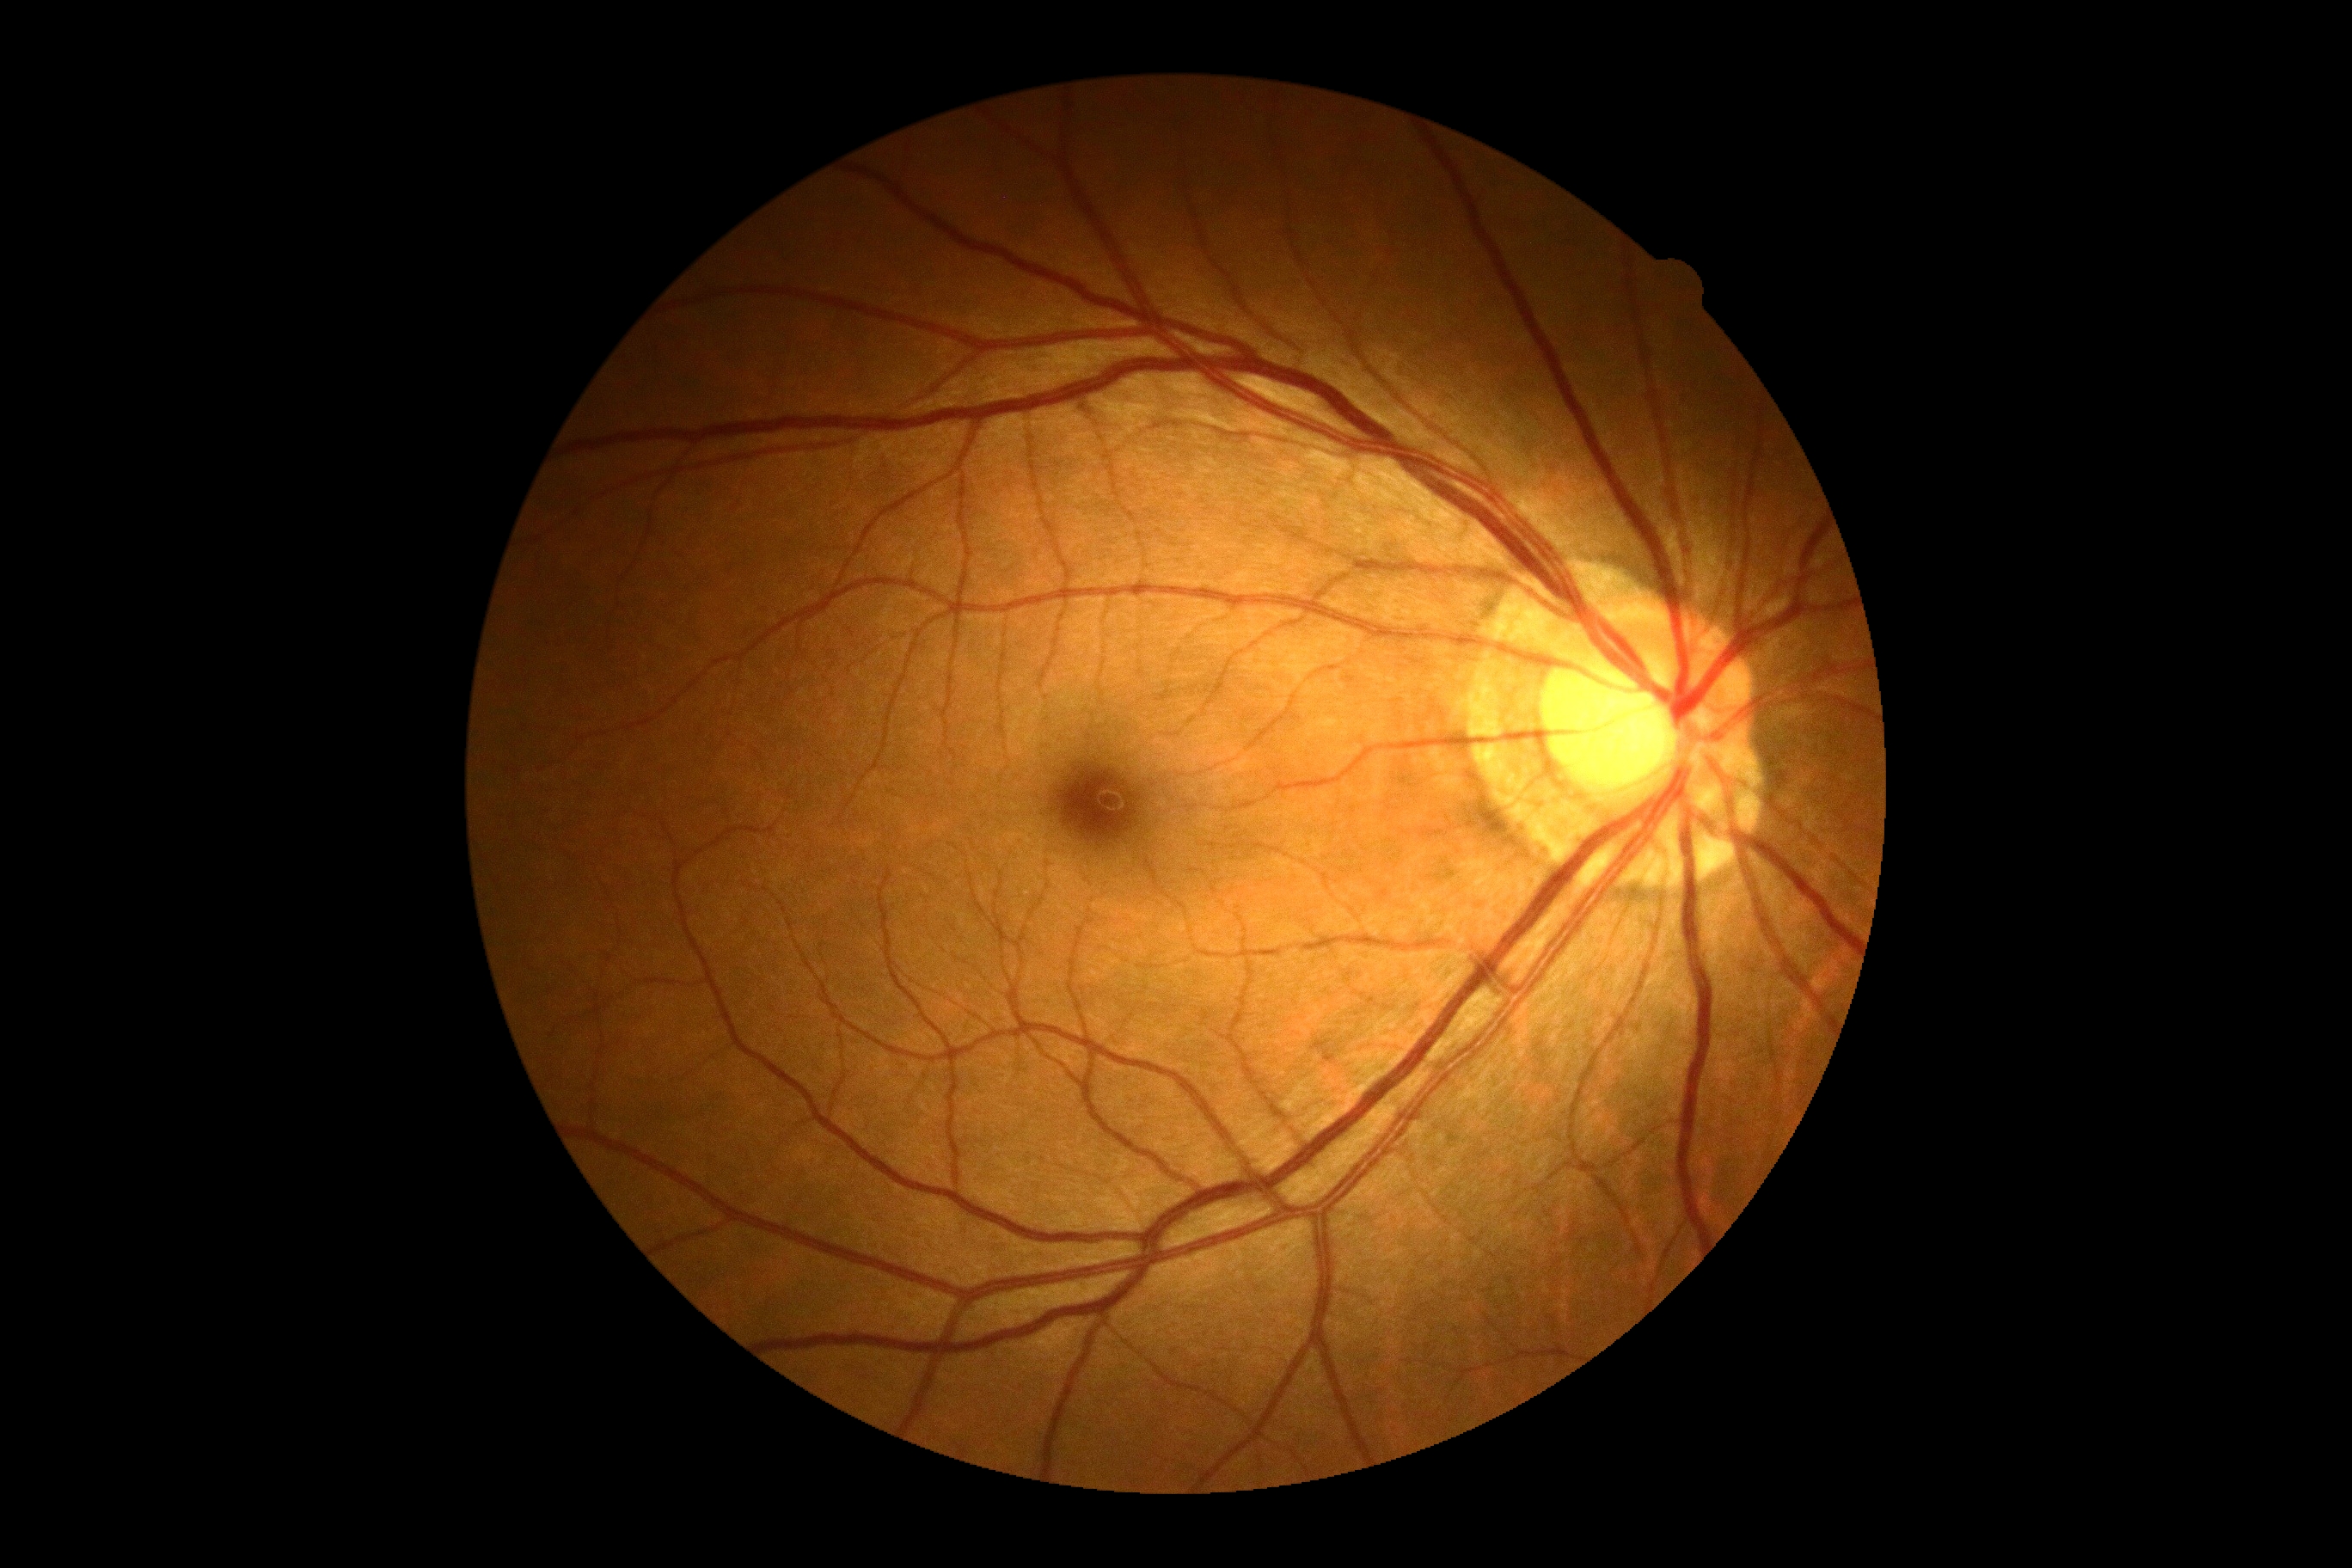
  dr_grade: 0